2048x1536.
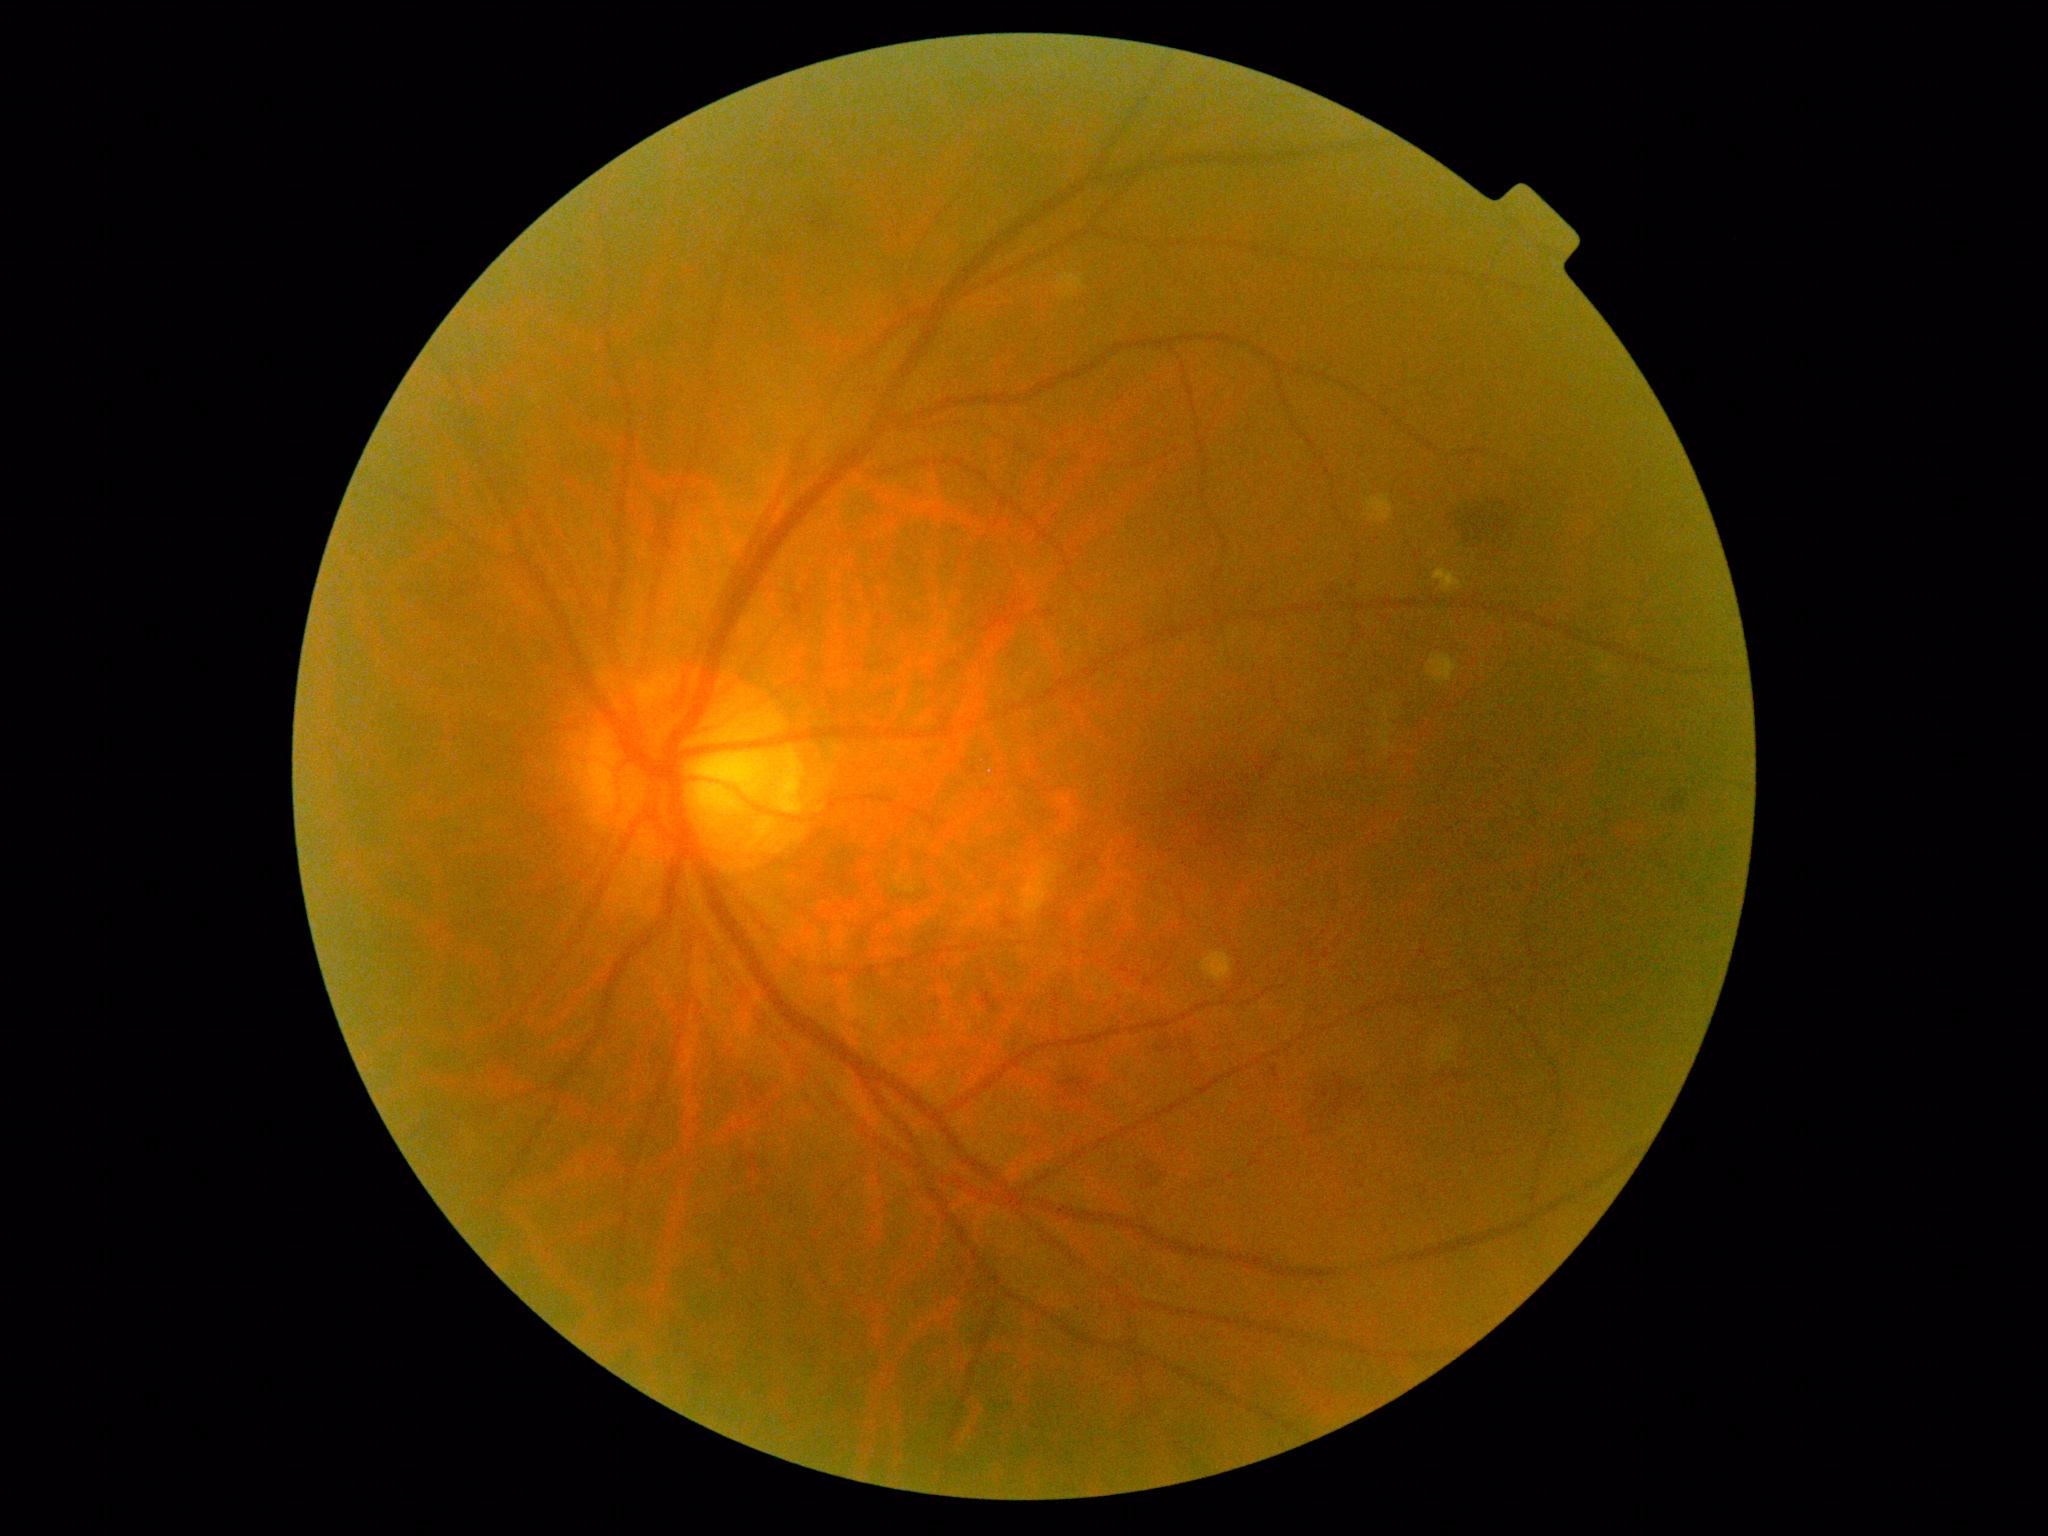
DR severity: grade 2 (moderate NPDR).